1440x1080px; acquired on the Natus RetCam Envision; infant wide-field fundus photograph — 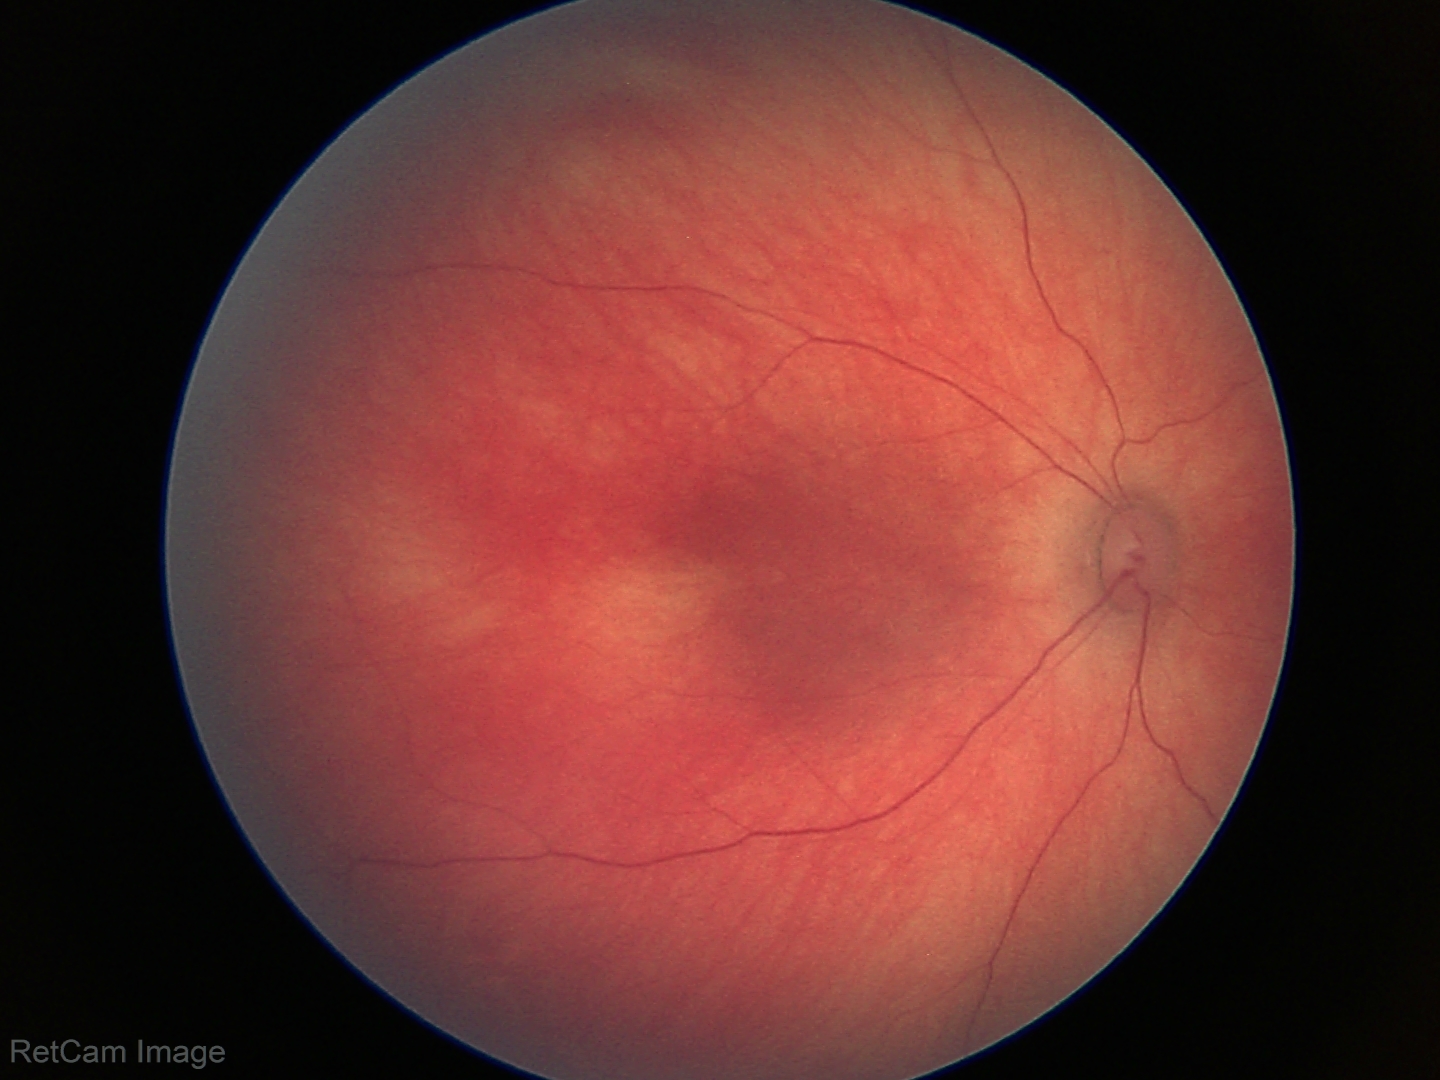

Physiological retinal appearance for postconceptual age.